Diabetic retinopathy graded by the modified Davis classification — 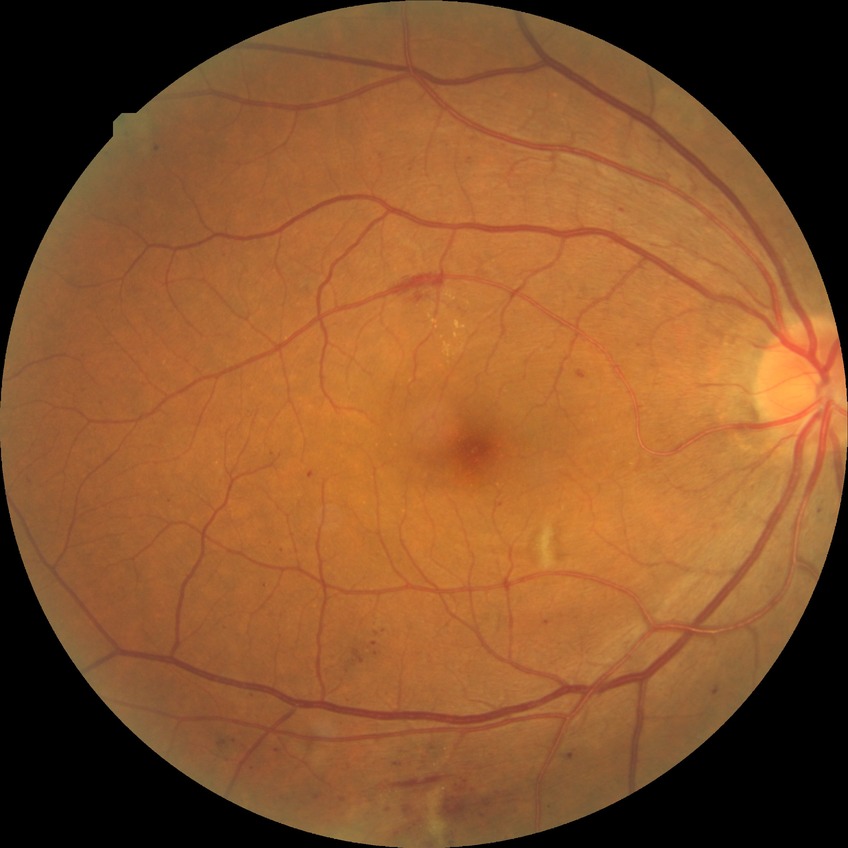
Modified Davis grading: pre-proliferative diabetic retinopathy.